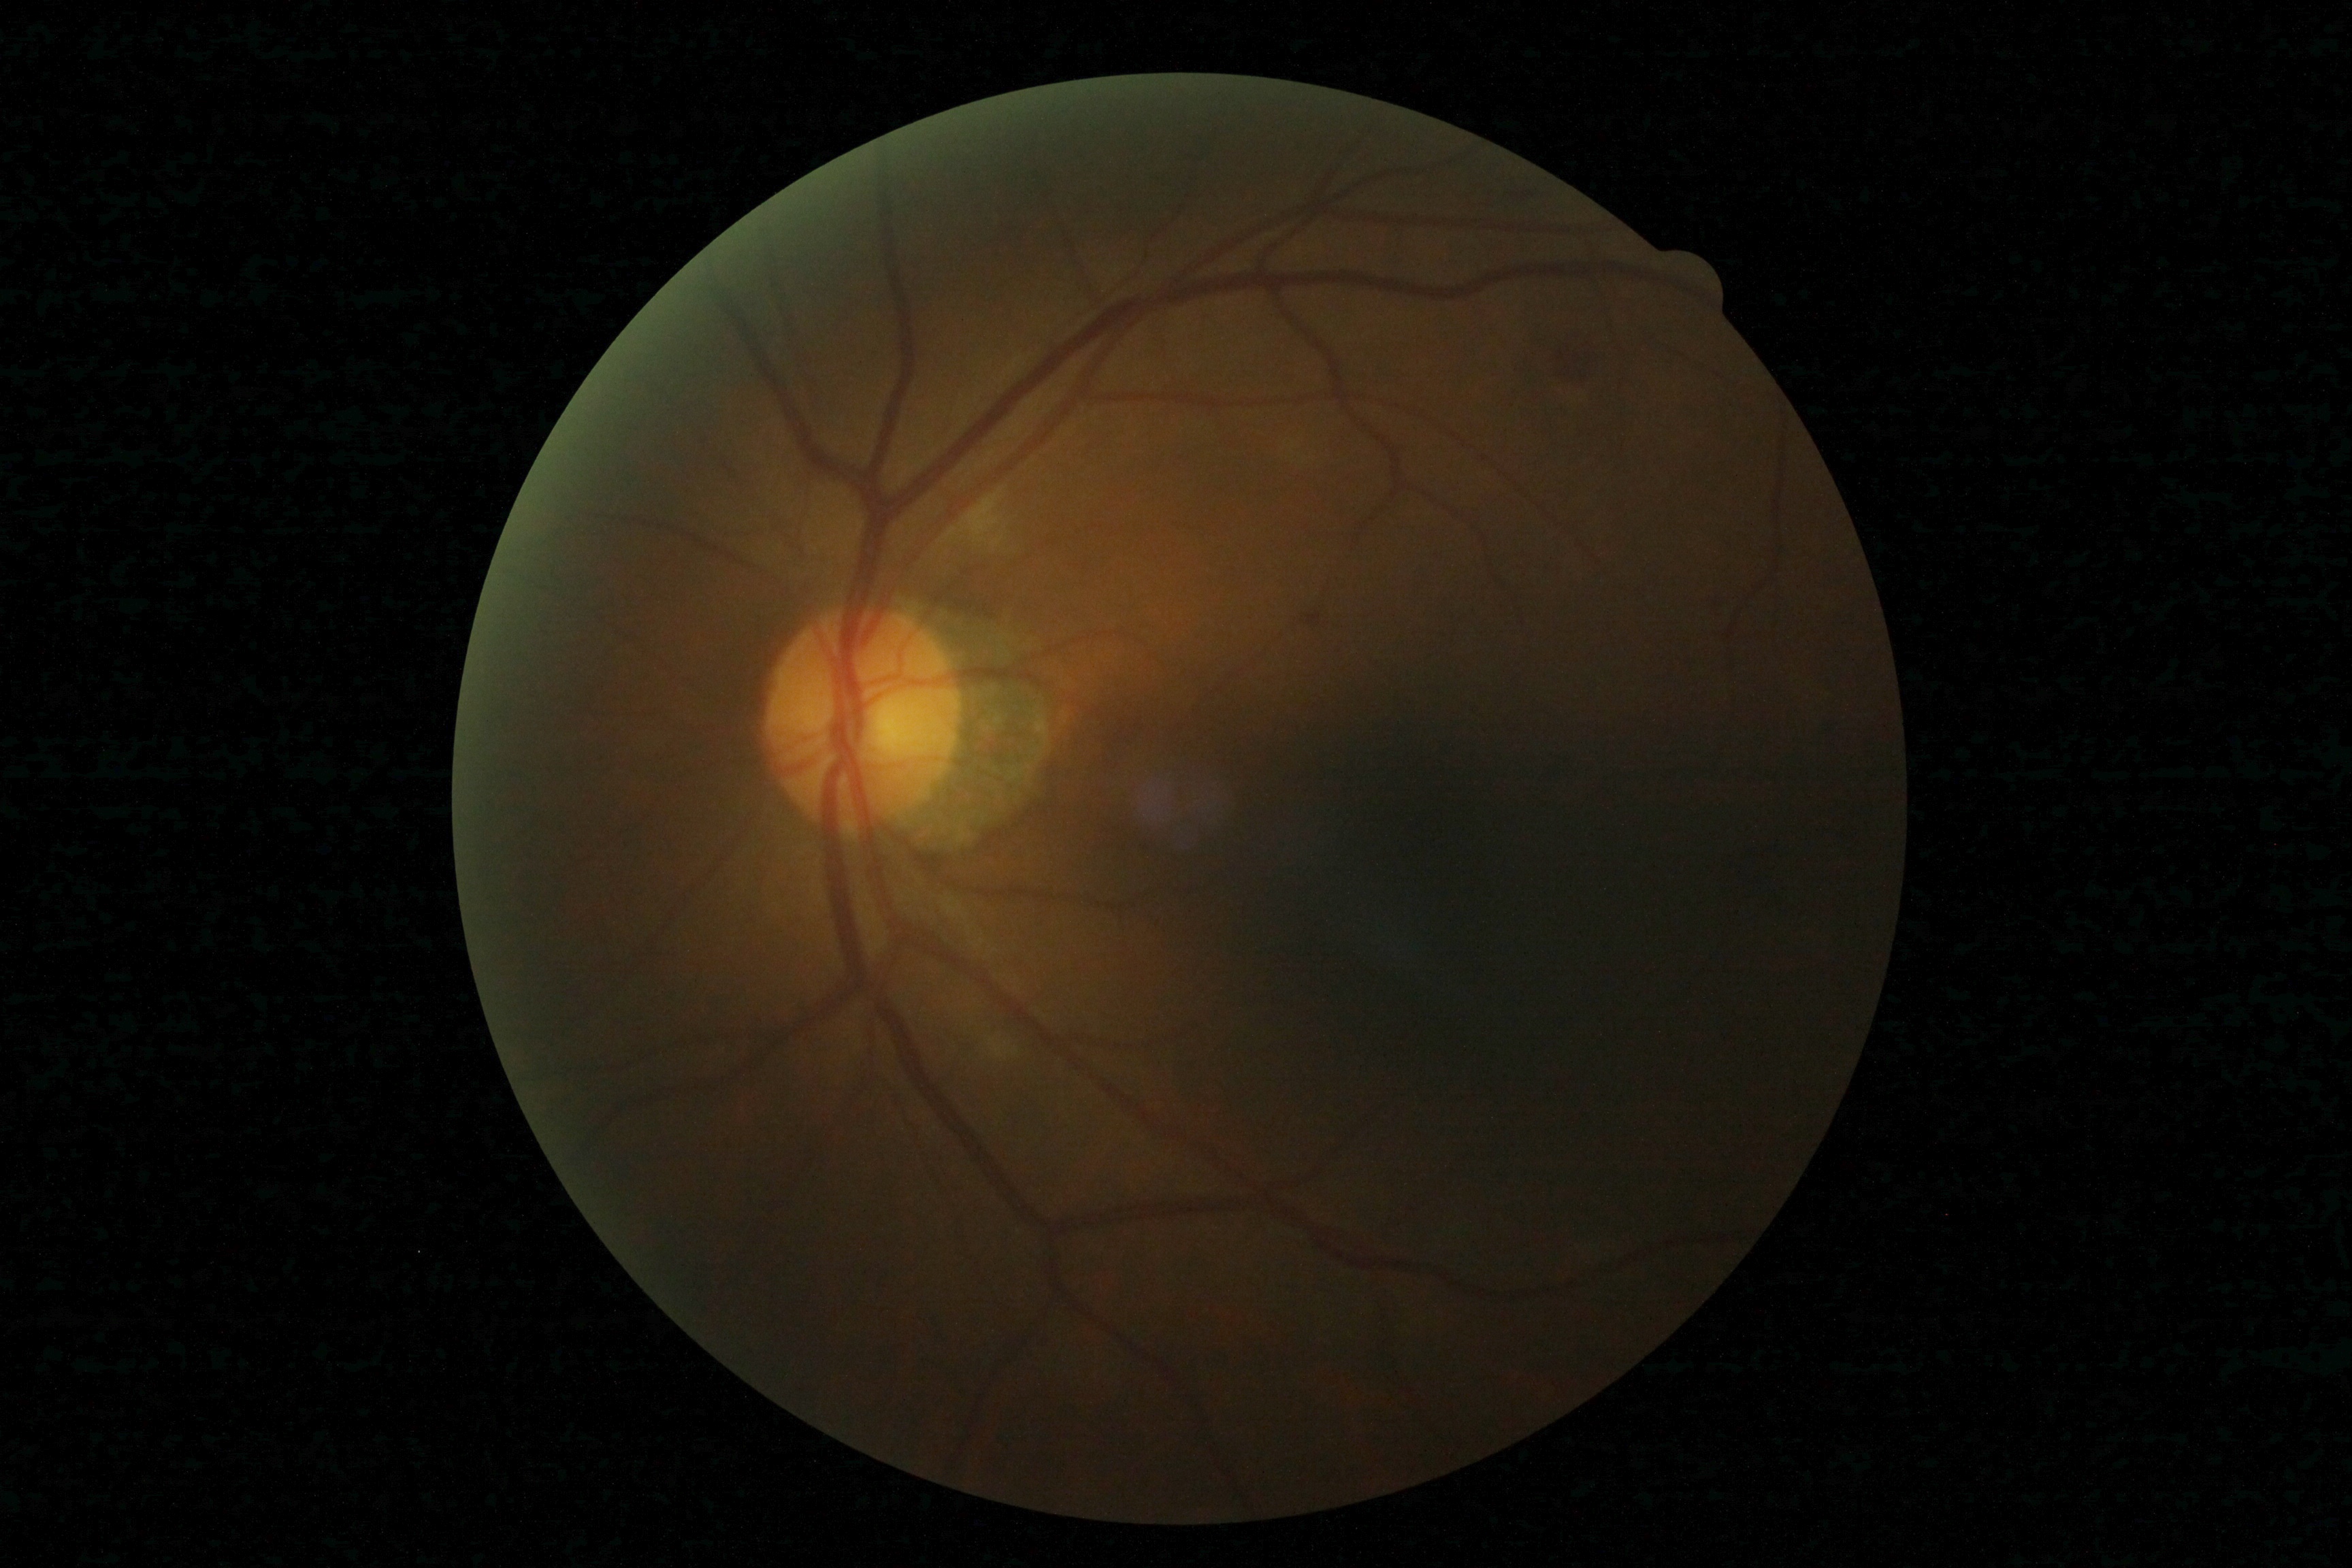
Diabetic retinopathy: moderate non-proliferative diabetic retinopathy (grade 2) — more than just microaneurysms but less than severe NPDR.